NIDEK AFC-230 — 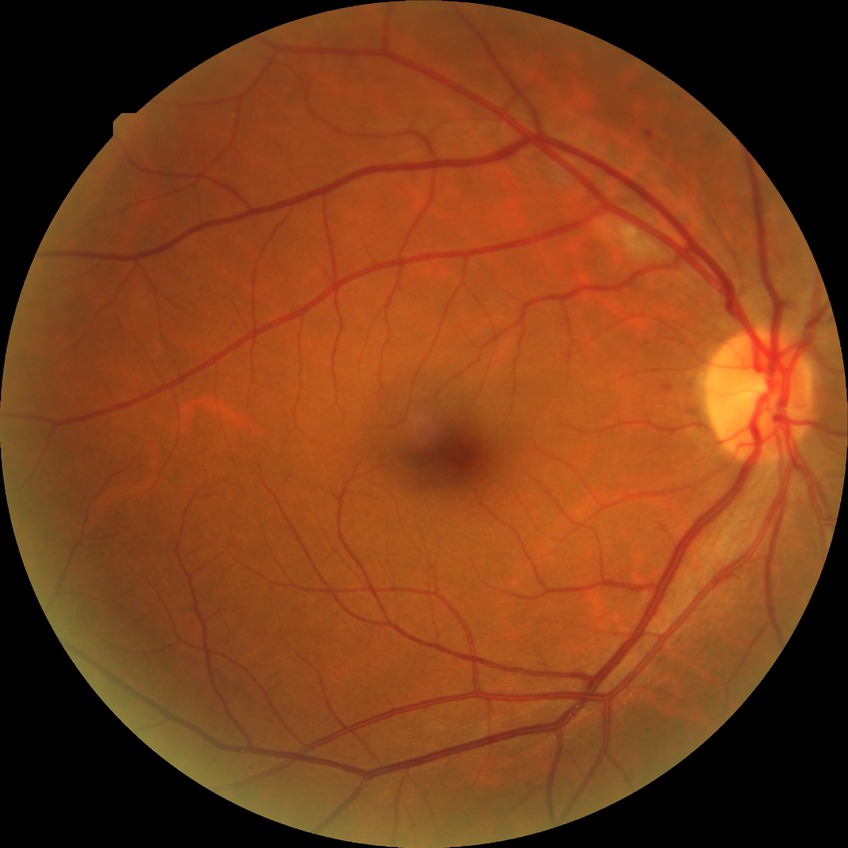
diabetic retinopathy (DR)=simple diabetic retinopathy (SDR).